512 by 512 pixels; CFP
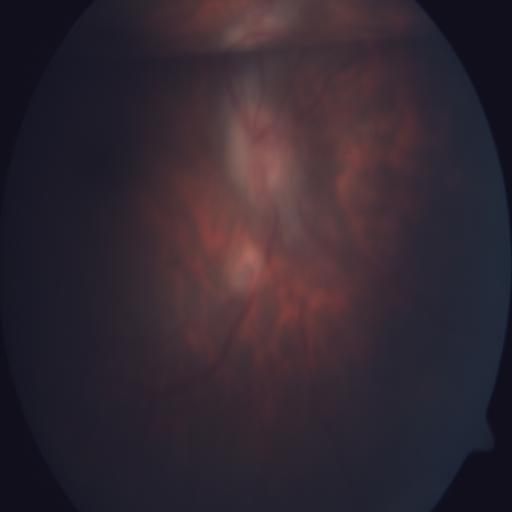 Abnormalities:
- optic disc edema (ODE)
- tessellation (TSLN)